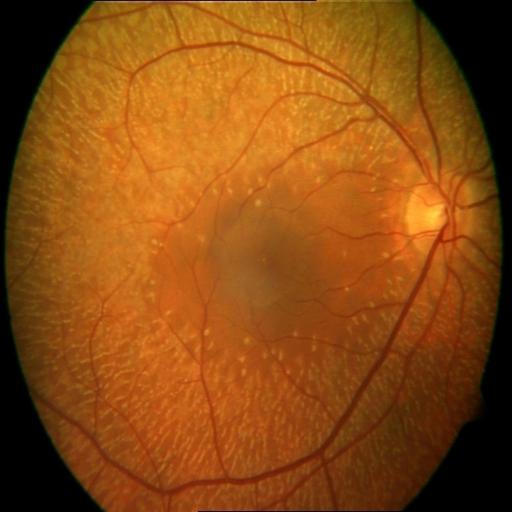
This fundus photograph shows retinitis pigmentosa.